NIDEK AFC-230 fundus camera; nonmydriatic fundus photograph; graded on the modified Davis scale; retinal fundus photograph; image size 848x848; 45° FOV:
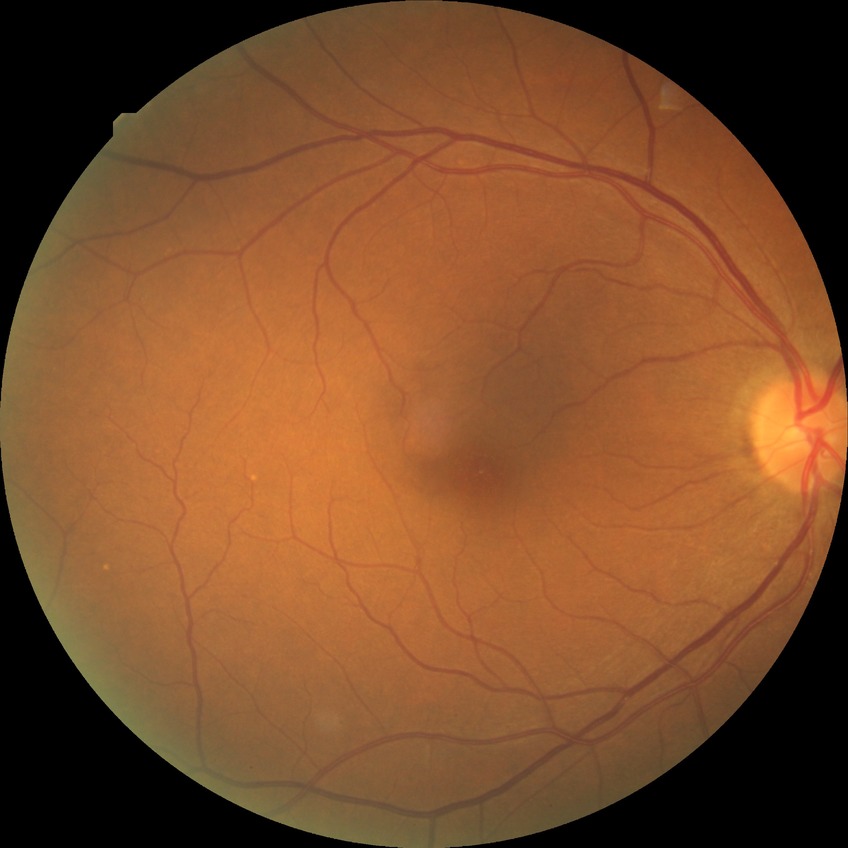

{
  "davis_grade": "NDR"
}